Color fundus photograph:
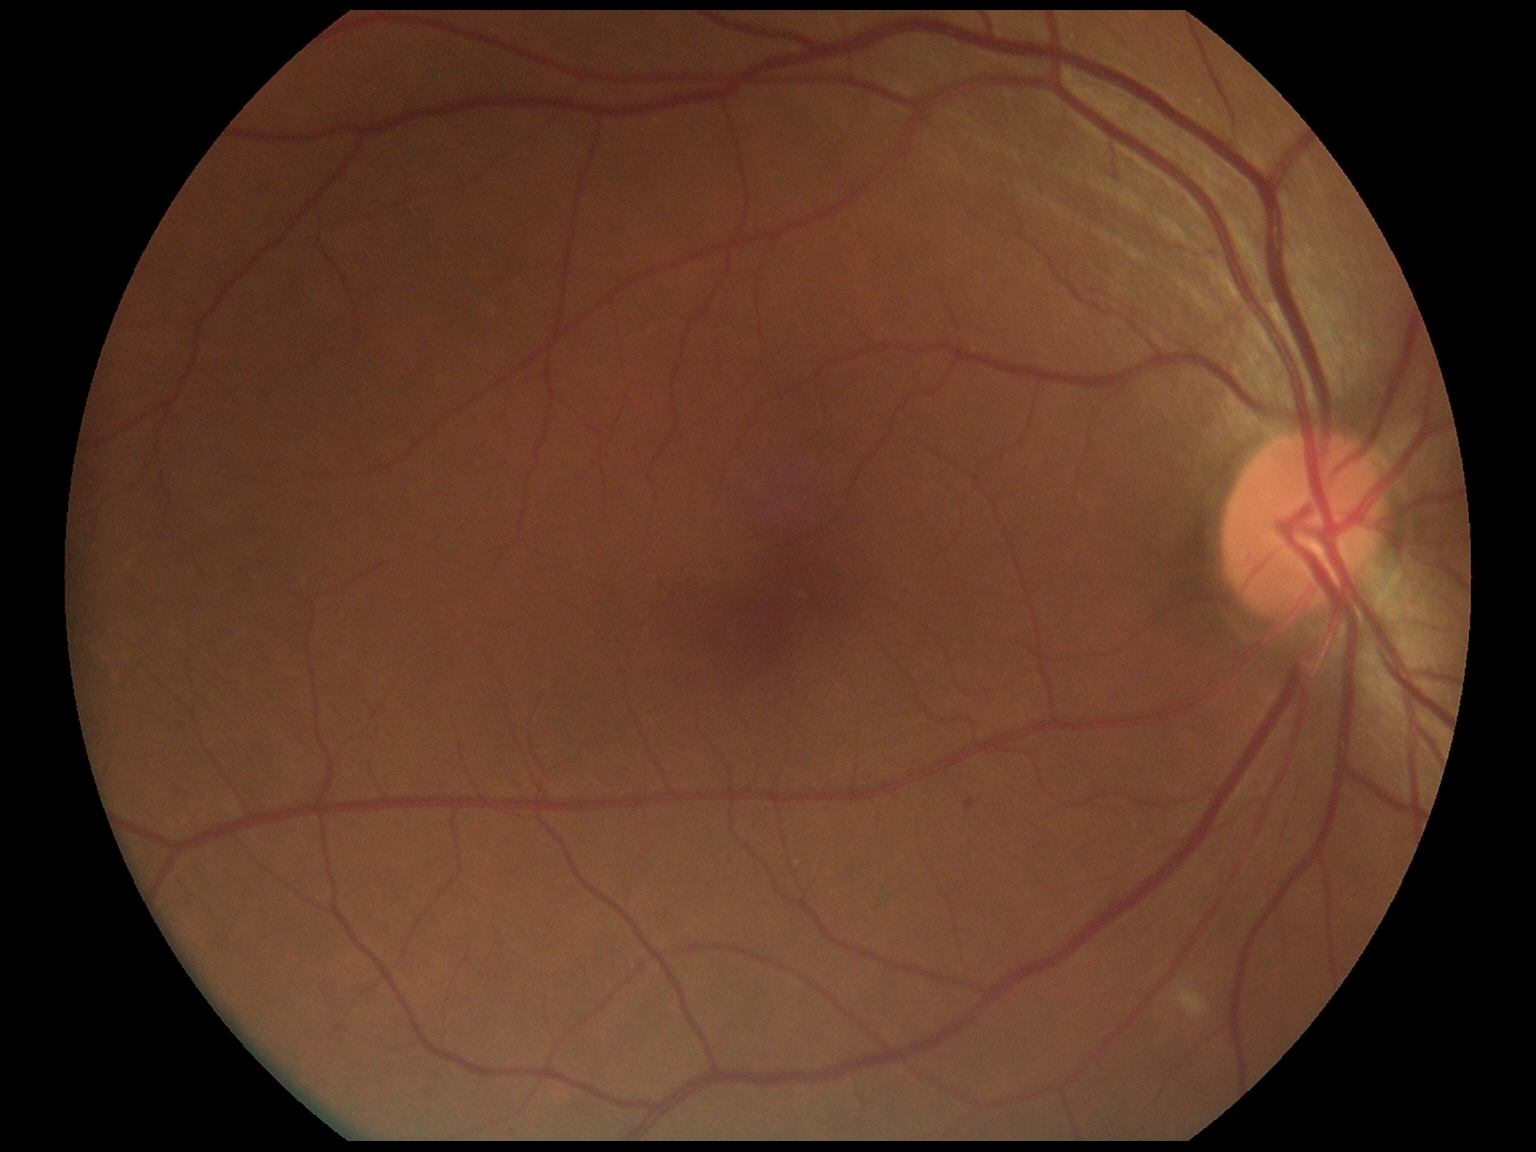
diabetic retinopathy (DR): moderate non-proliferative diabetic retinopathy (grade 2) — more than just microaneurysms but less than severe NPDR.